Wide-field fundus photograph of an infant. Camera: Clarity RetCam 3 (130° FOV). 640x480 — 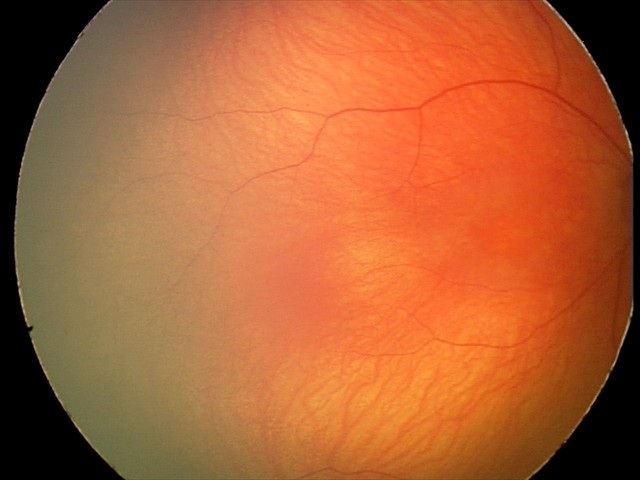
Assessment: no abnormalities.